Nonmydriatic, color fundus image, 848x848px.
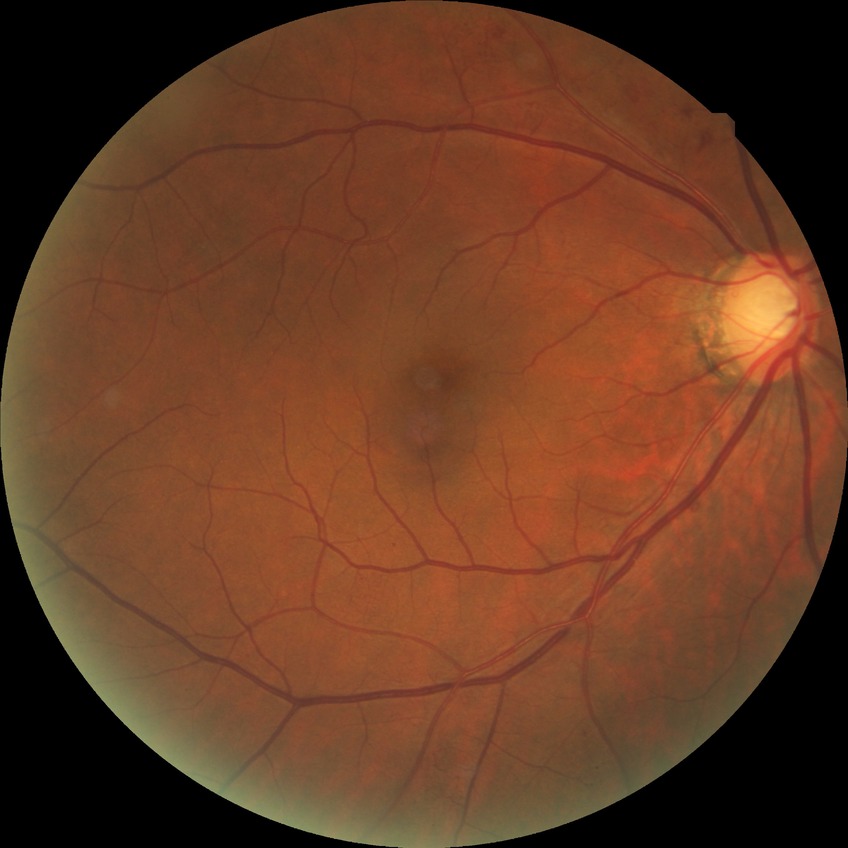 Diabetic retinopathy severity is simple diabetic retinopathy.